Wide-field fundus photograph from neonatal ROP screening:
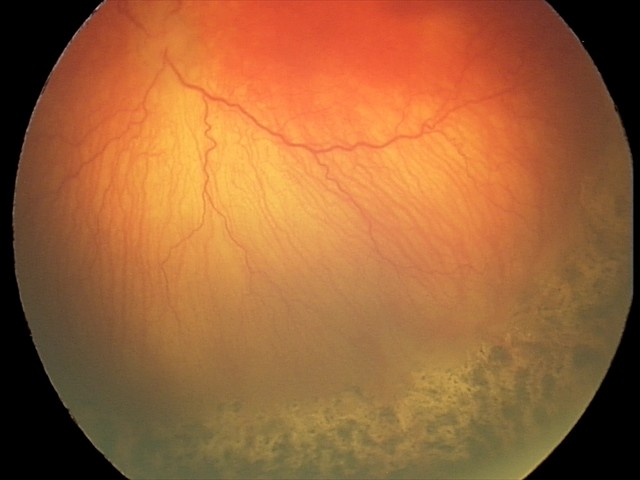

Q: What is the screening diagnosis?
A: aggressive retinopathy of prematurity — rapidly progressive severe ROP with prominent plus disease, often without classic stage progression
Q: Plus disease status?
A: plus disease